Camera: Nidek AFC-330: 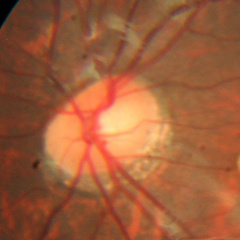
Impression = no glaucomatous findings.